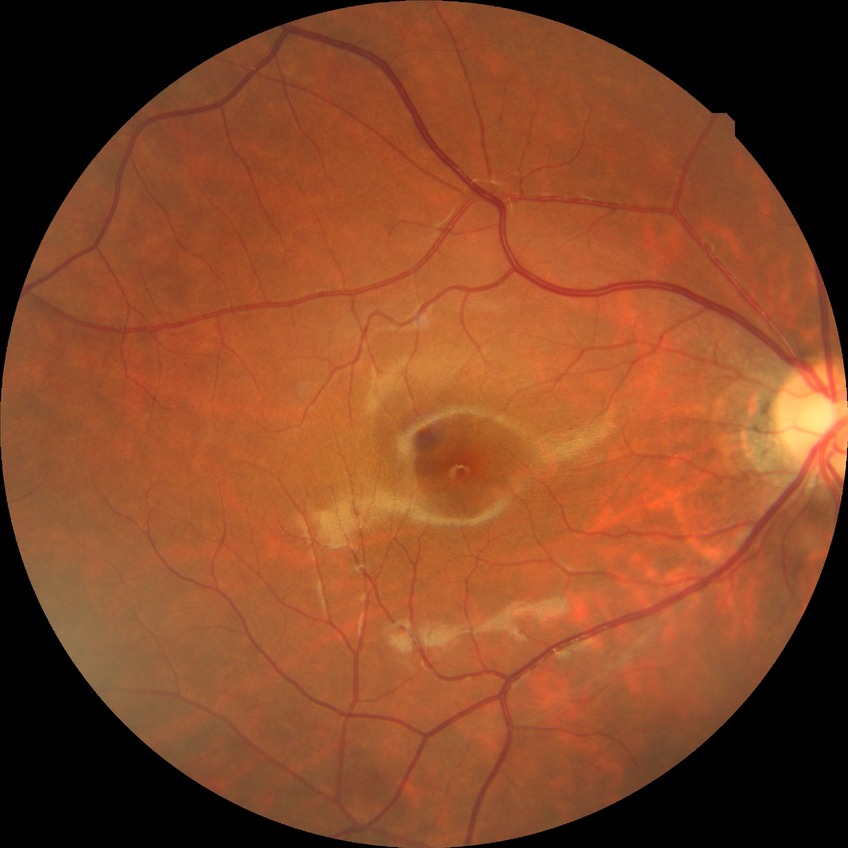

Modified Davis grade: SDR.